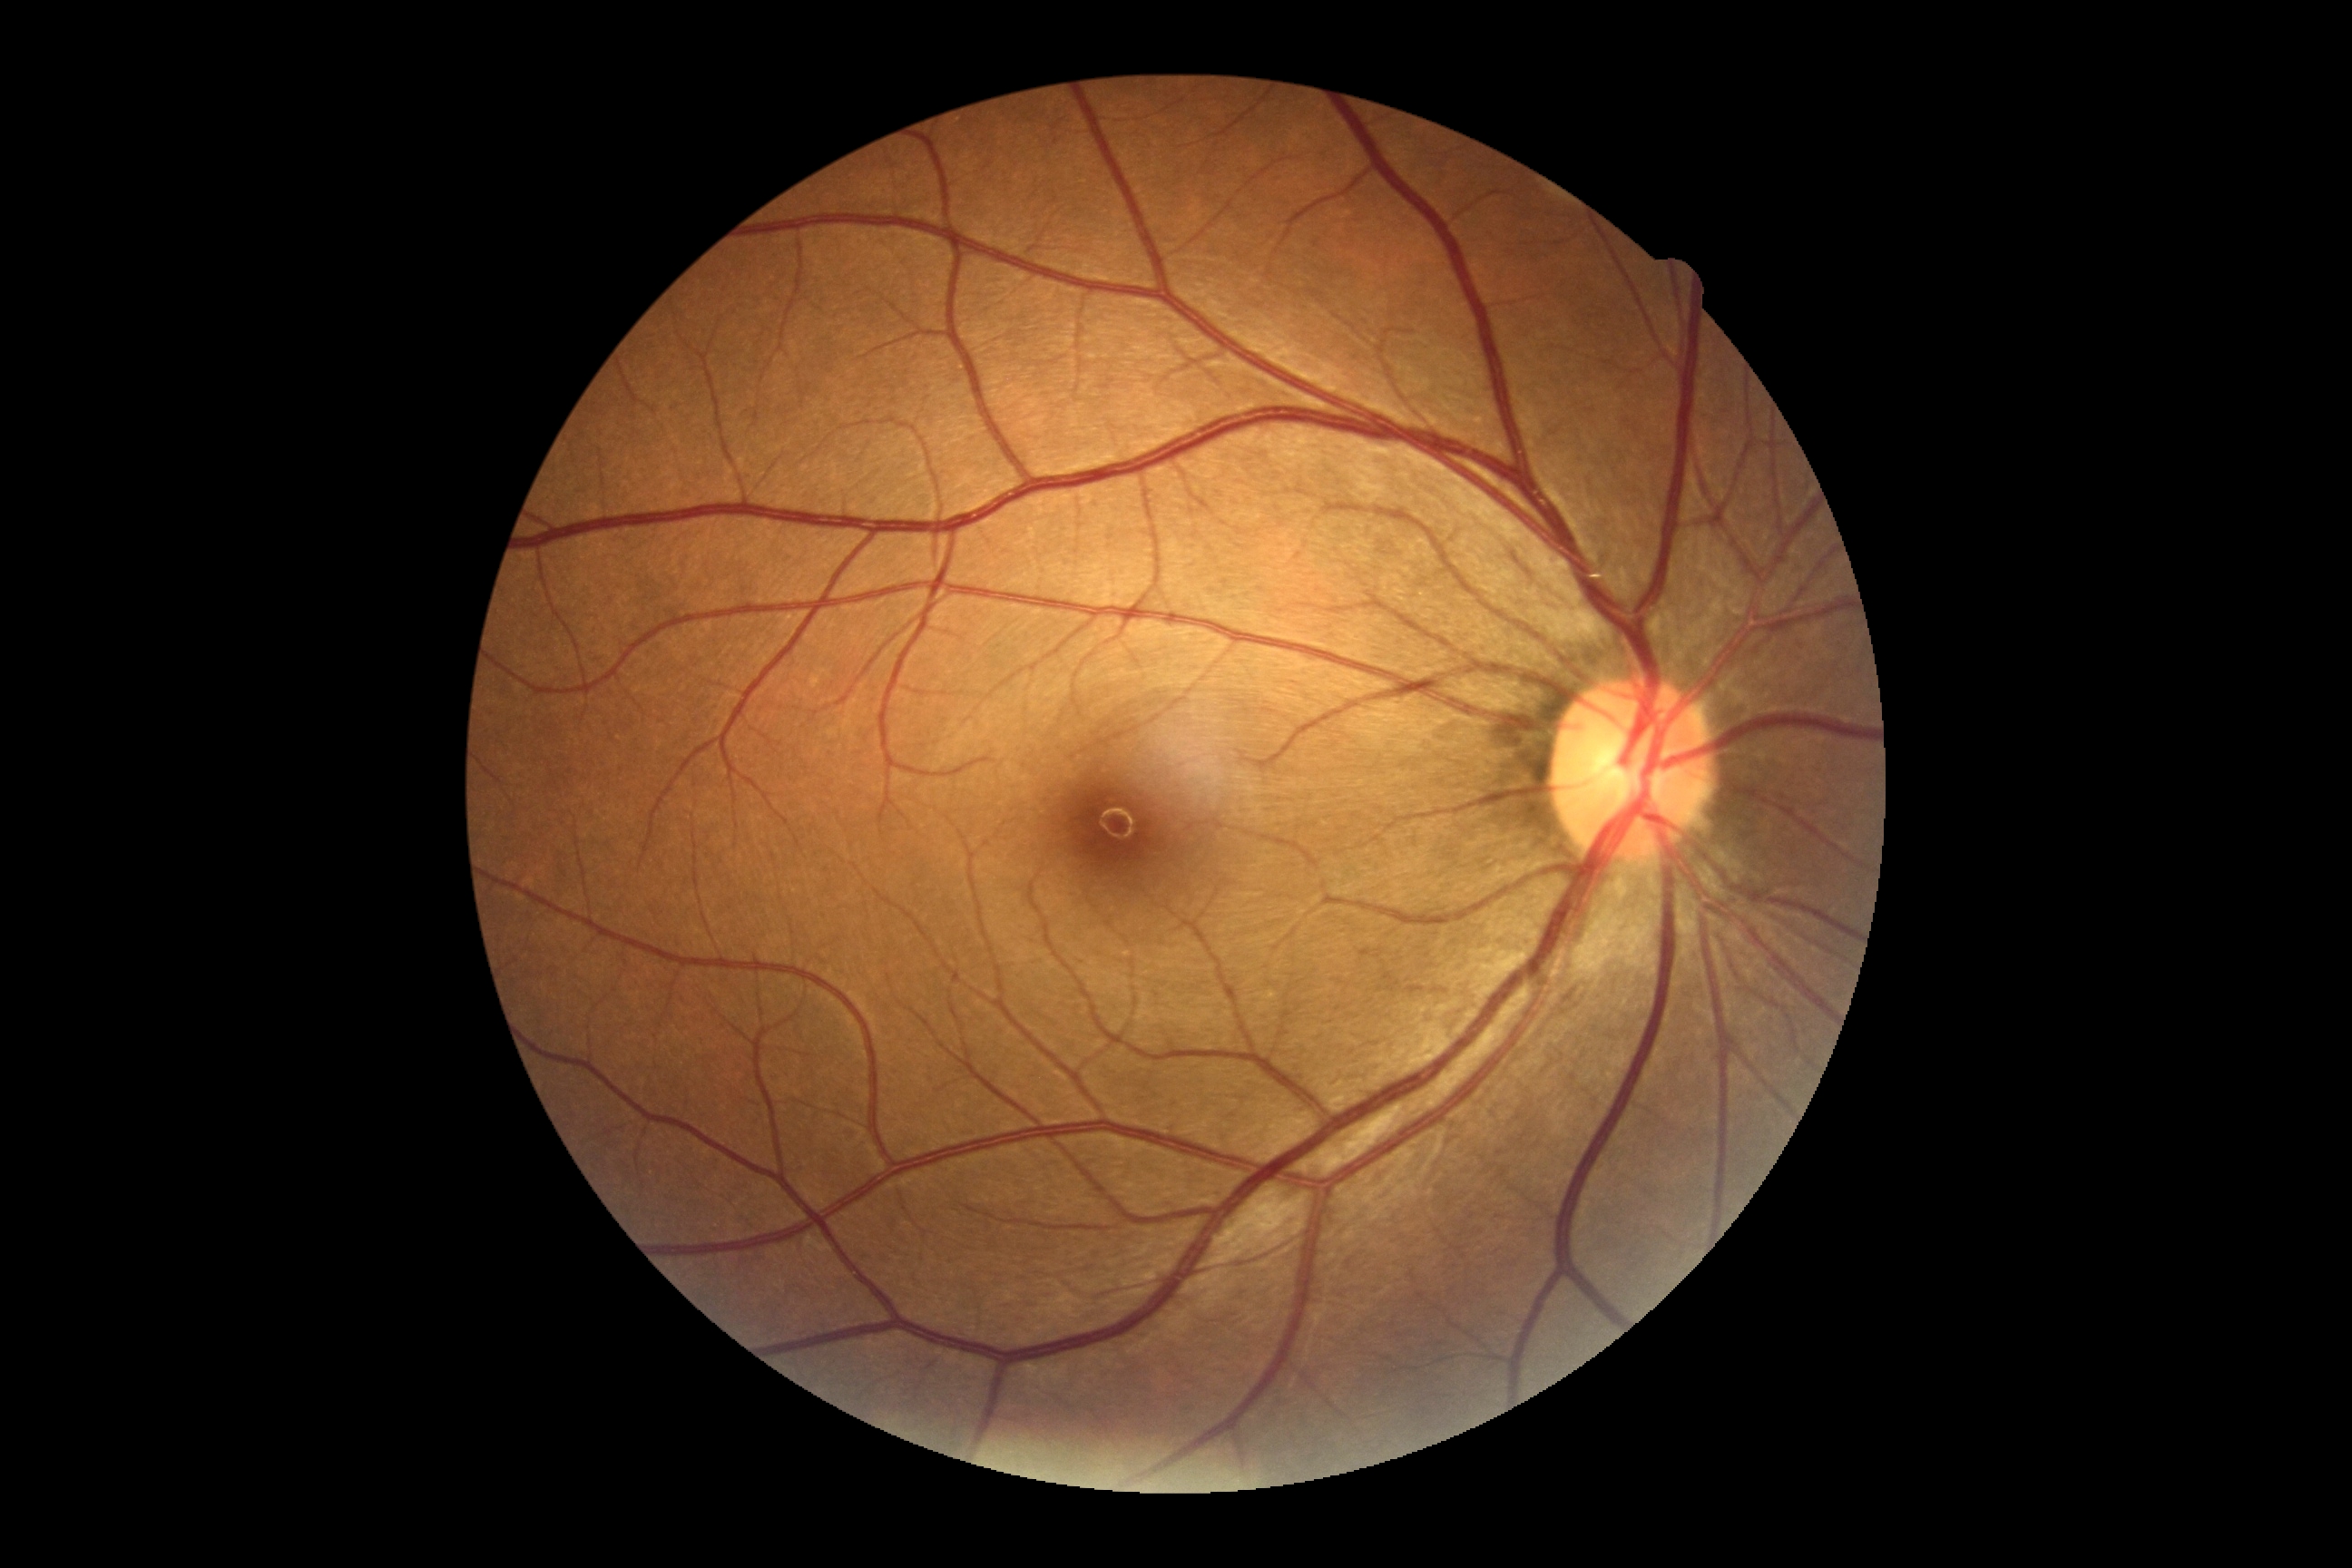

DR grade: no apparent retinopathy (0) — no visible signs of diabetic retinopathy.